2352x1568px, 45° FOV, color fundus image — 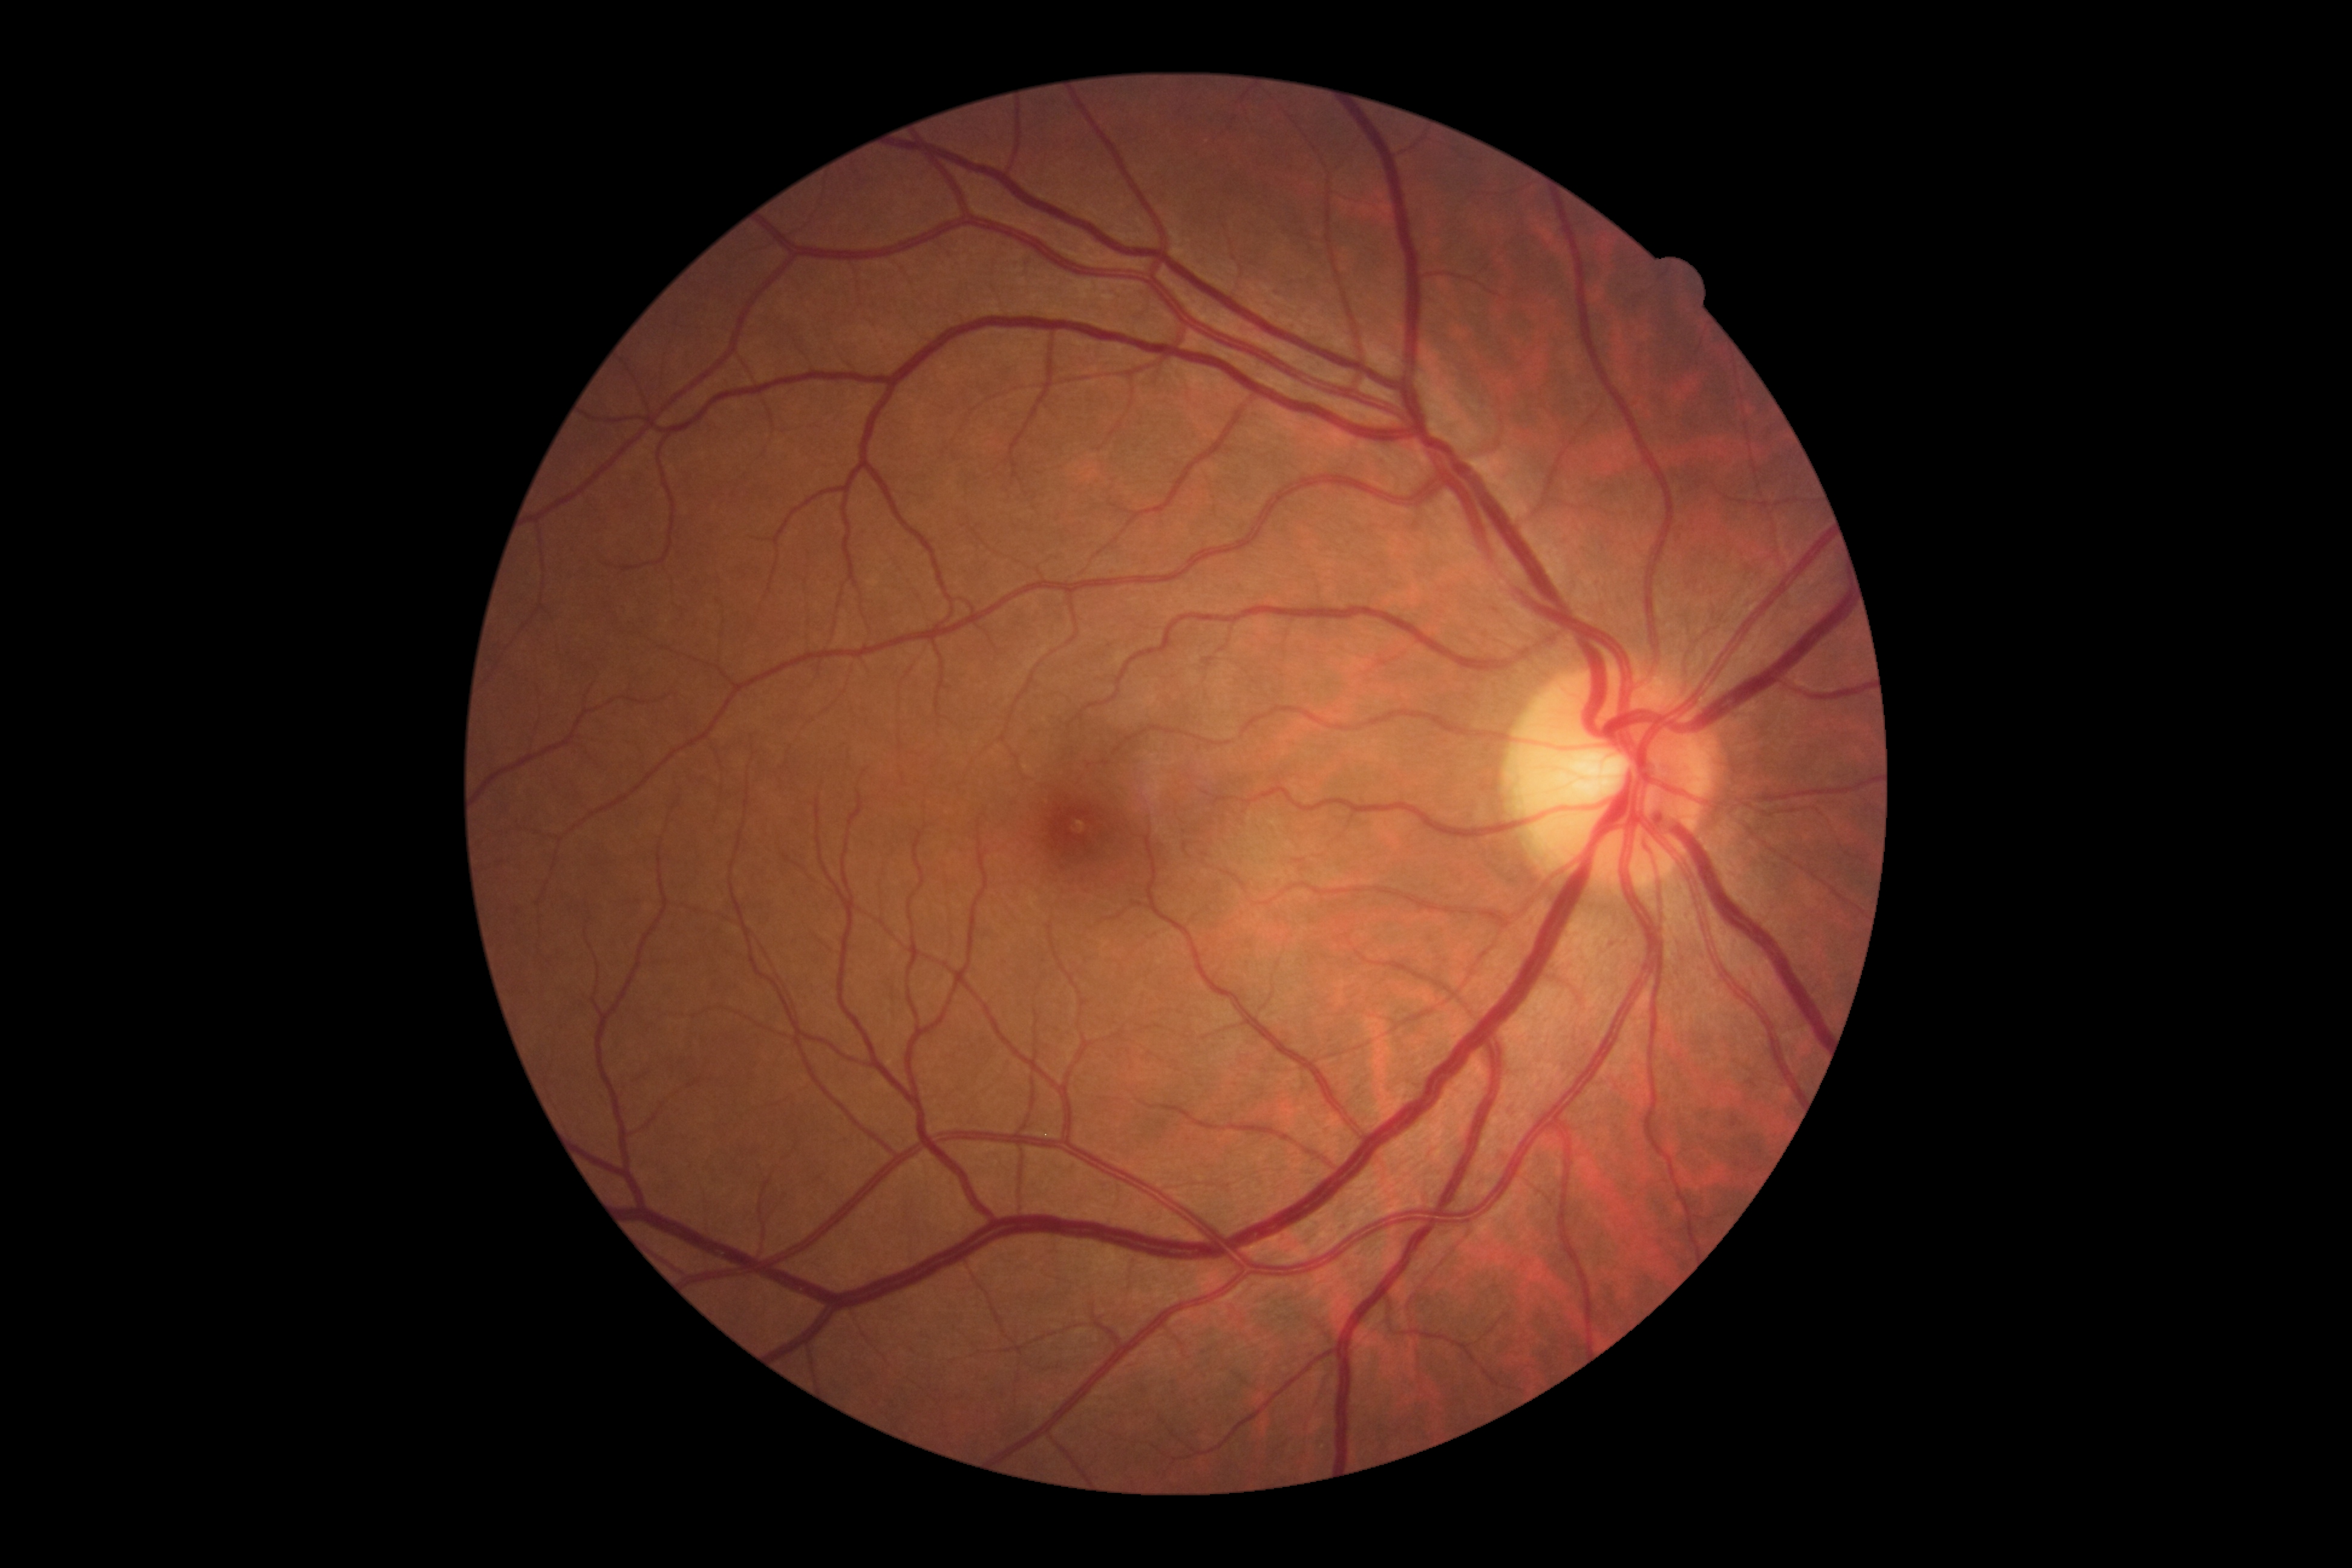

Diabetic retinopathy severity is 0.